ONH-centered crop from a color fundus image · Topcon TRC fundus camera · 850 by 850 pixels:
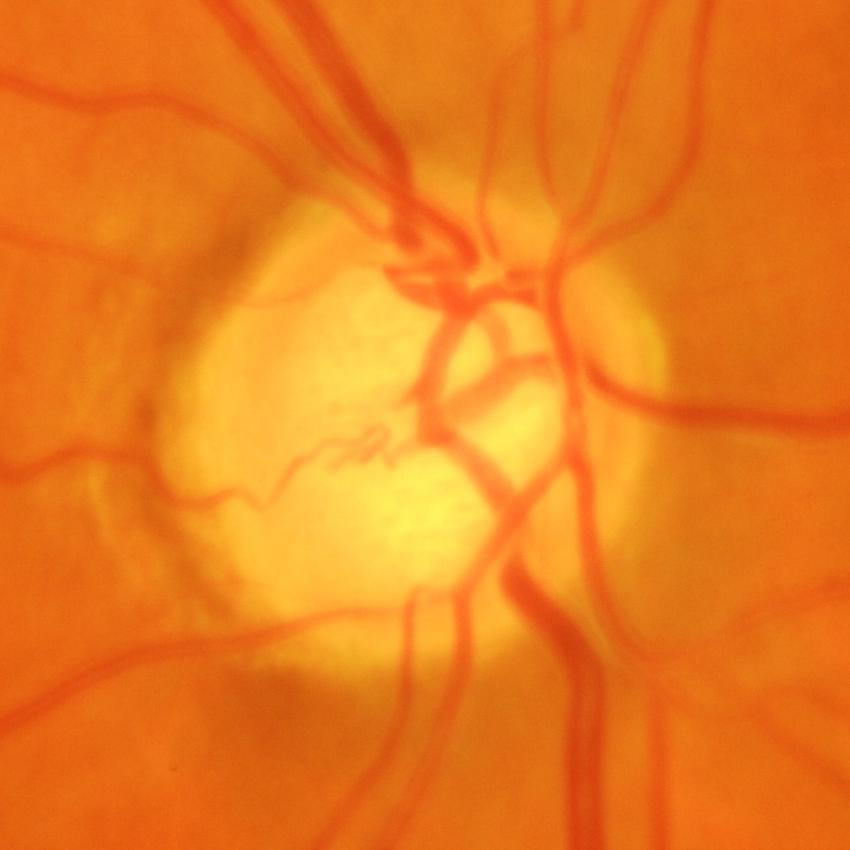 Q: What is the glaucoma diagnosis?
A: Yes — glaucomatous changes.